45° field of view: 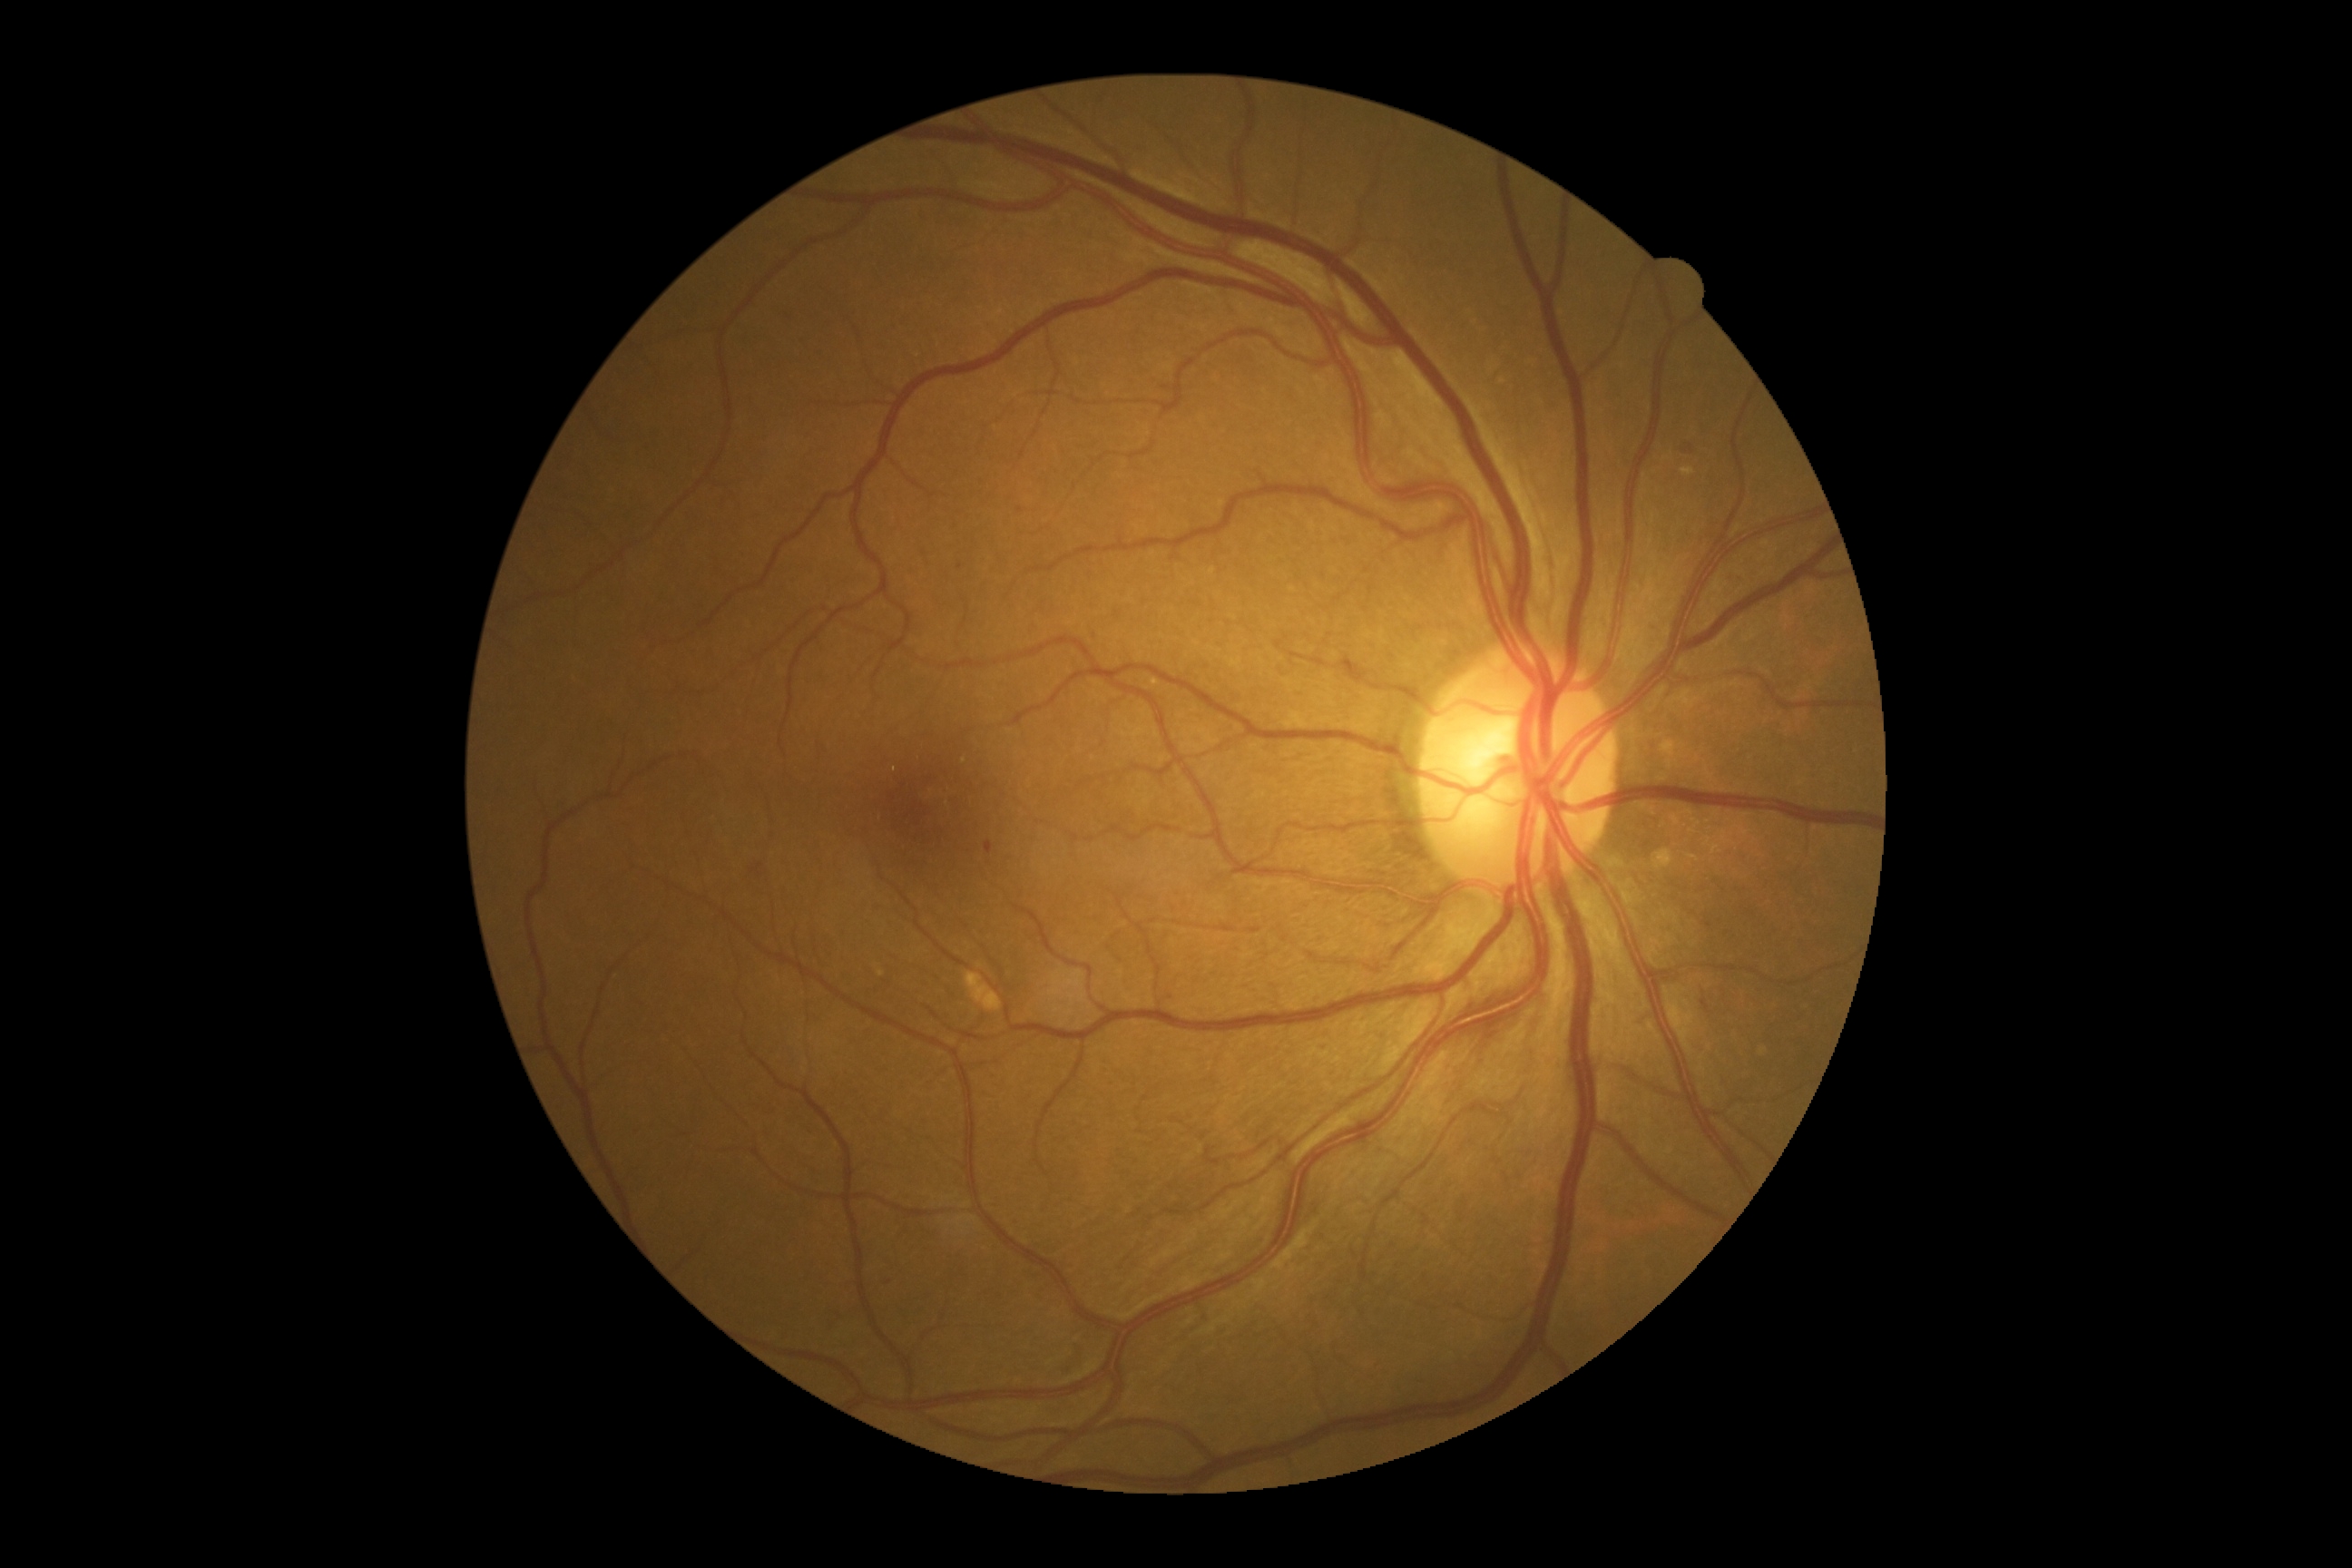
DR severity is 2.